Nonmydriatic — 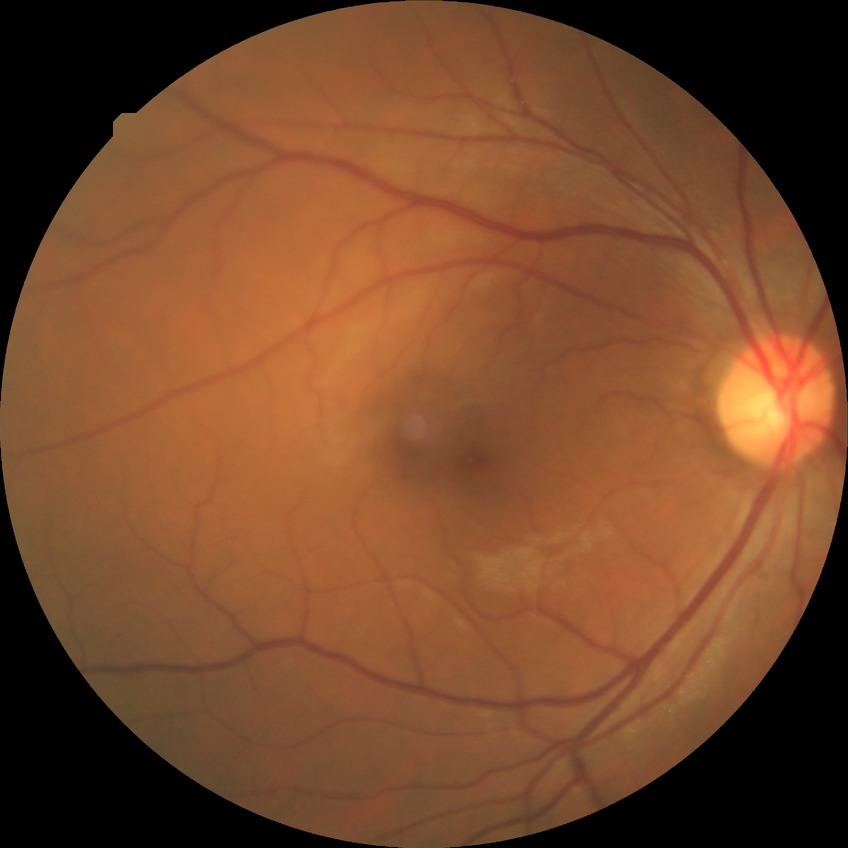

{
  "davis_grade": "no diabetic retinopathy (NDR)"
}